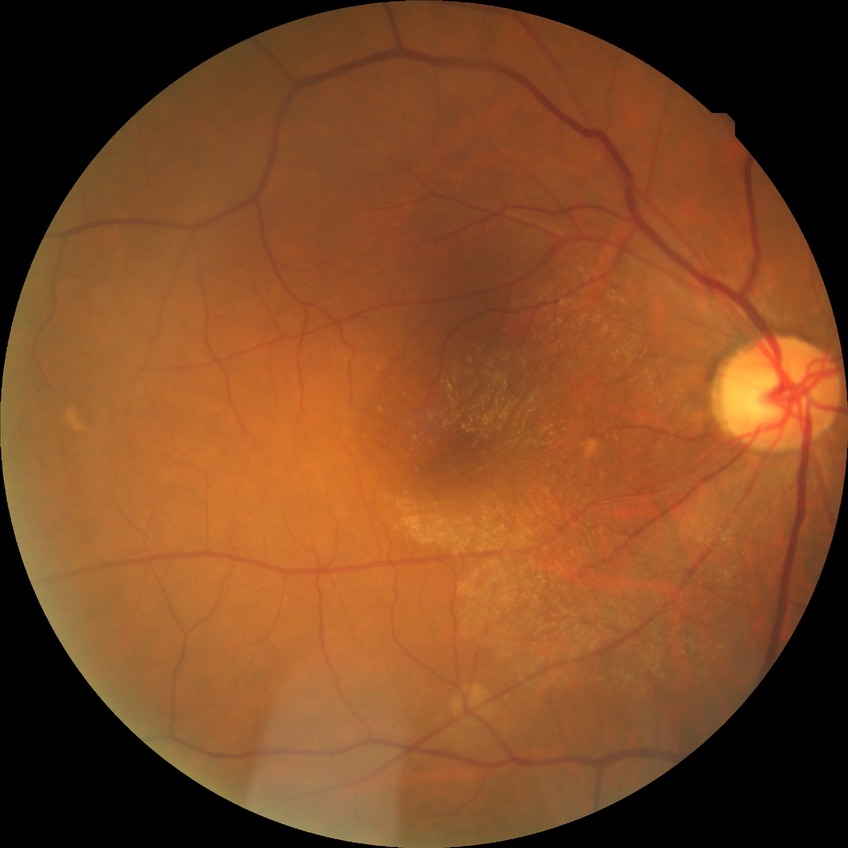 Annotations:
* diabetic retinopathy (DR): NDR (no diabetic retinopathy)